2352x1568; retinal fundus photograph; 45° FOV.
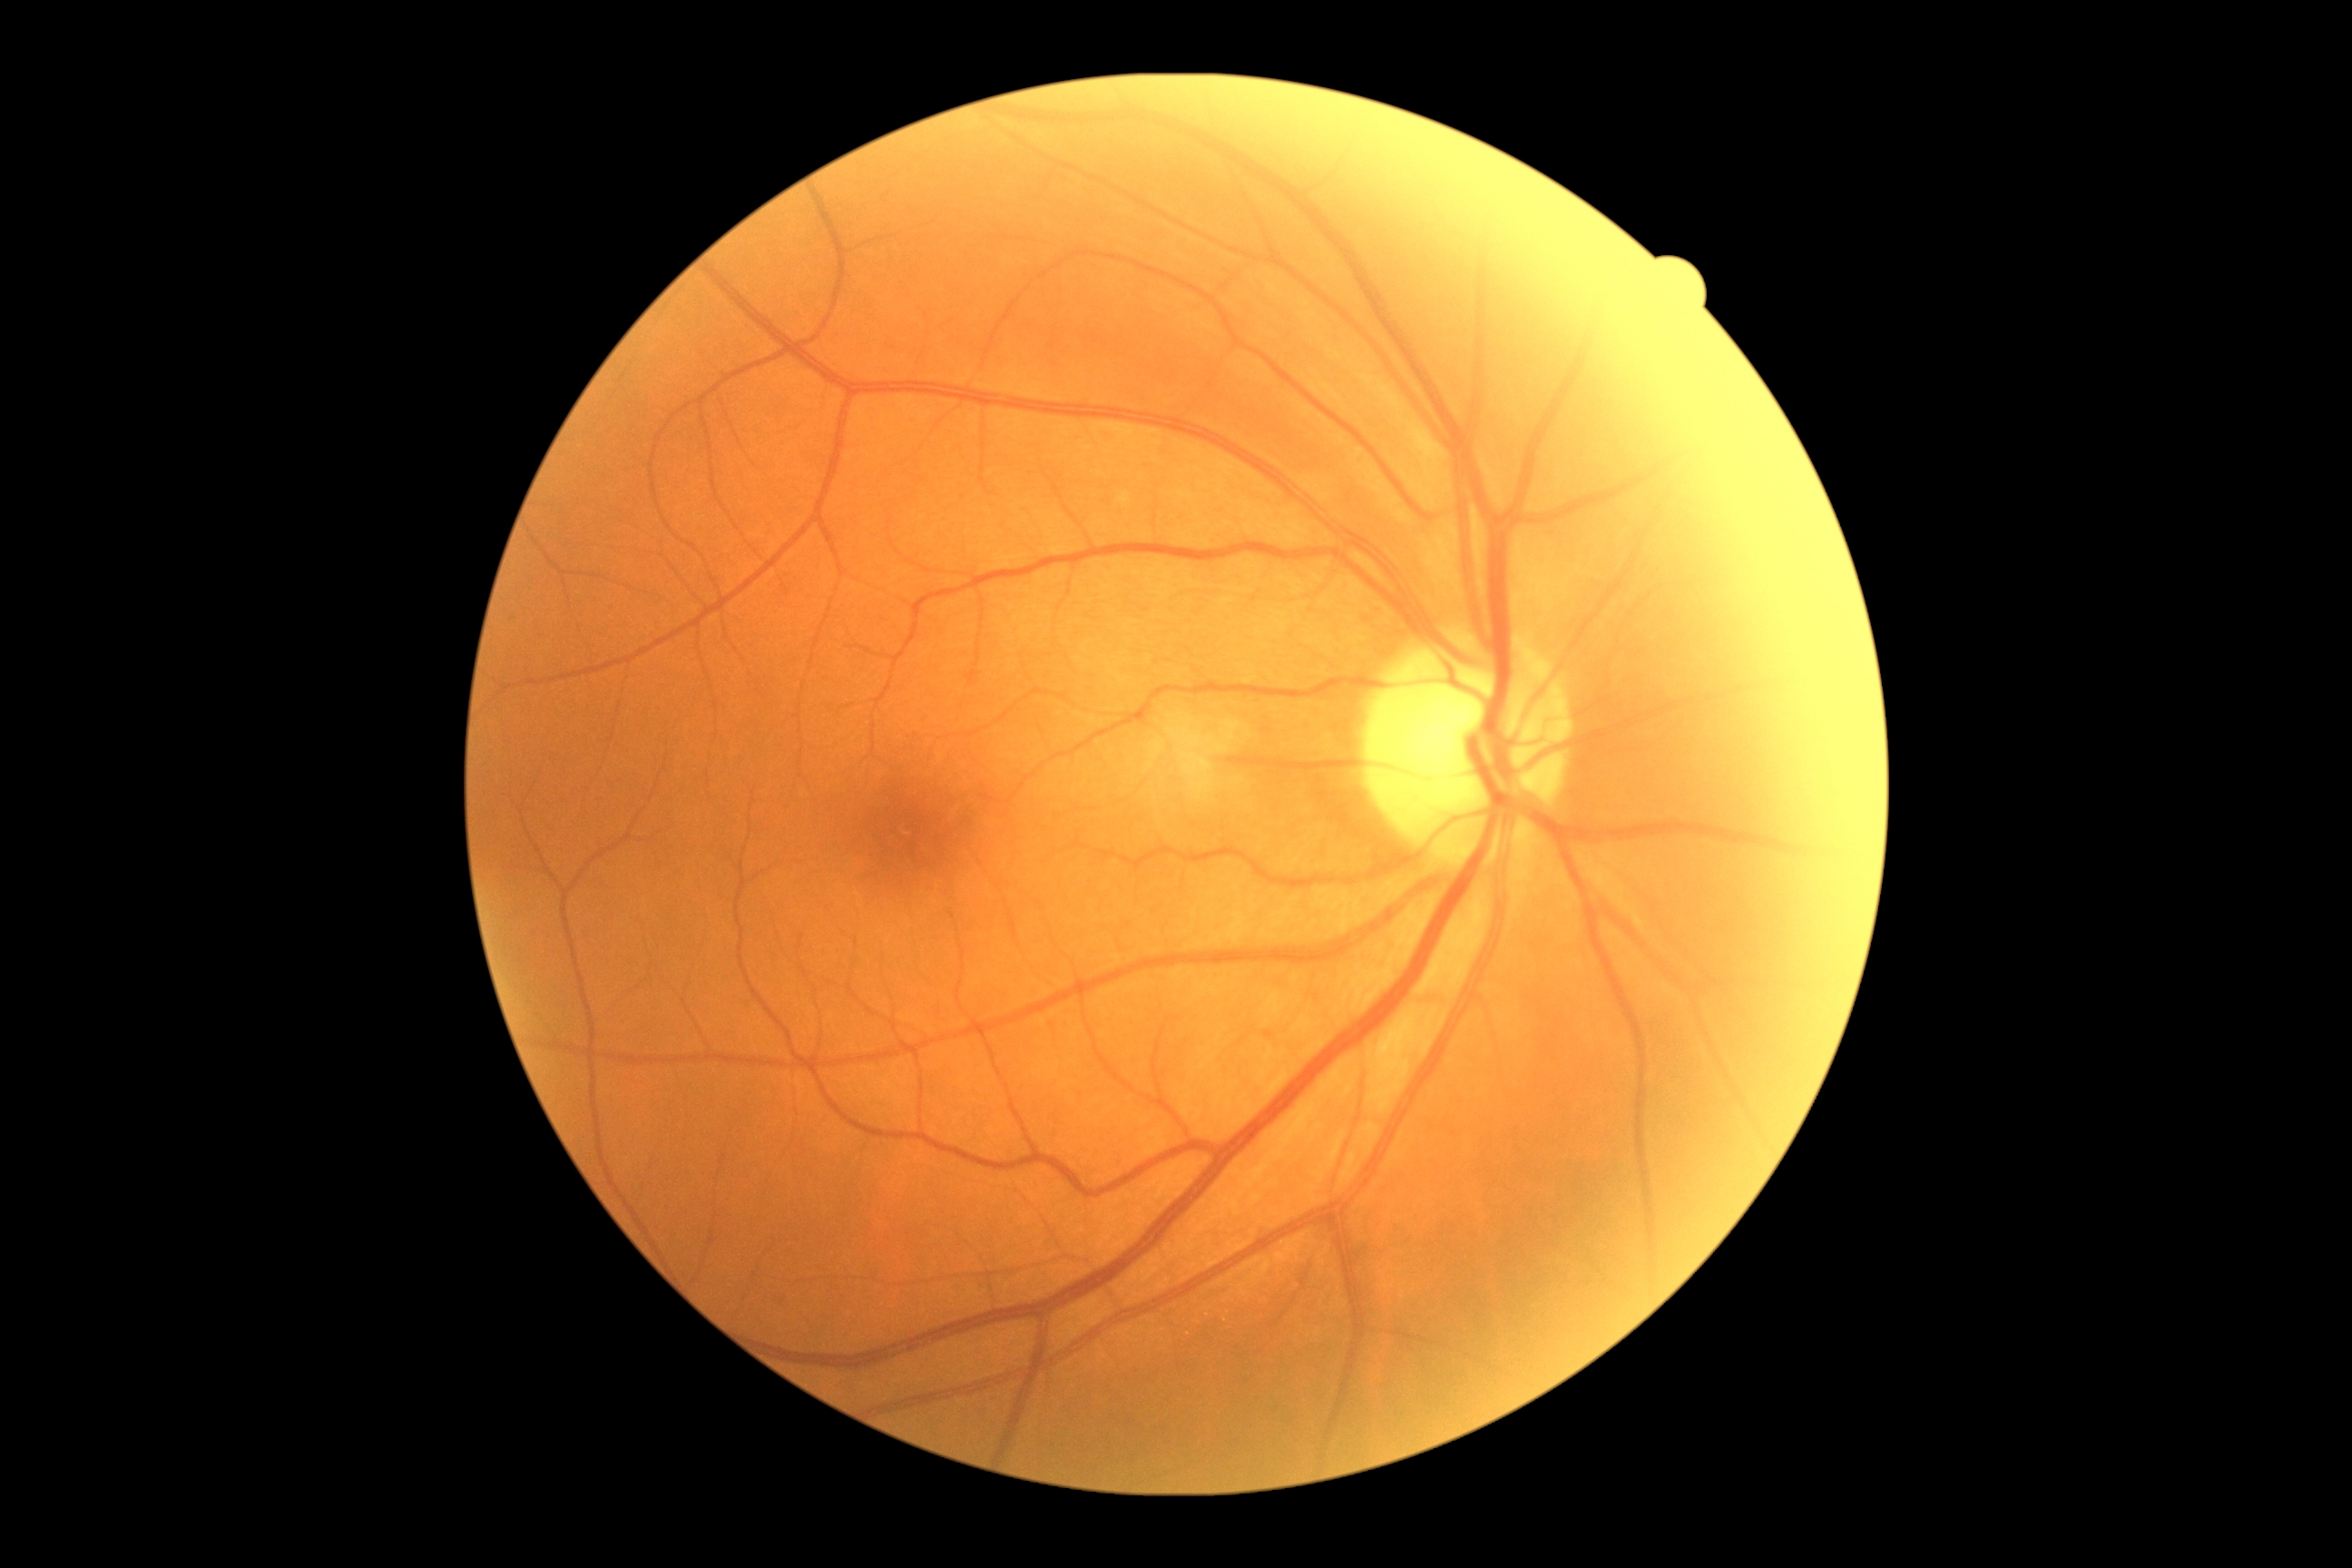

  dr_impression: no apparent DR
  dr_grade: 0